Wide-field retinal mosaic image — 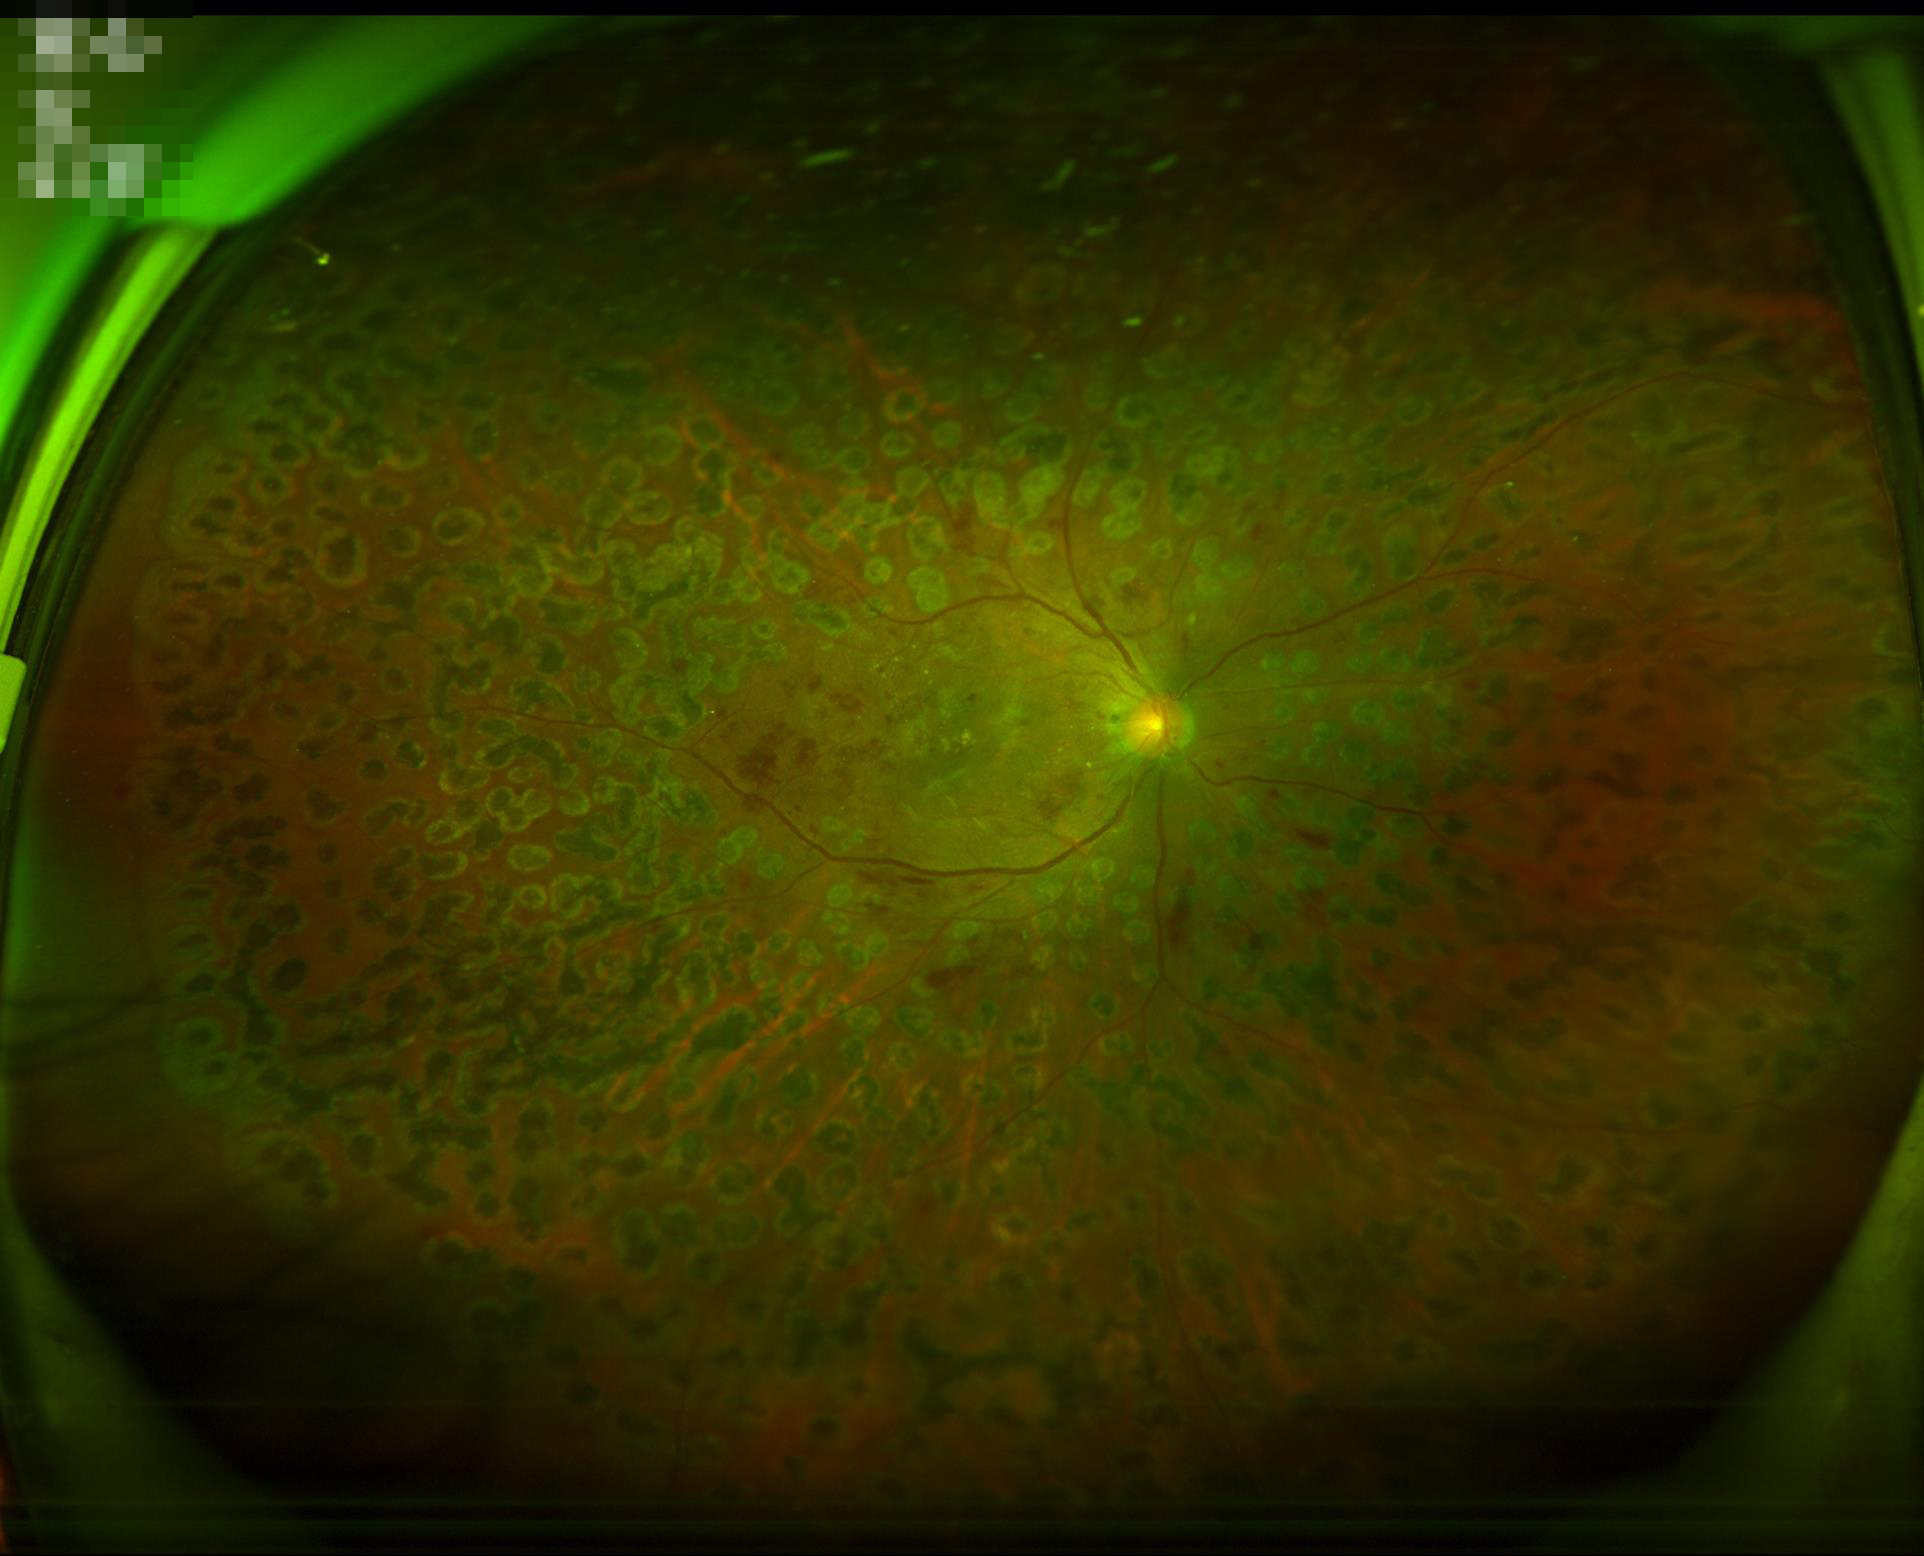 No over- or under-exposure.
Vessels and details are readily distinguishable.
Image quality is adequate for diagnostic use.
No noticeable blur.